FOV: 45 degrees; color fundus photograph: 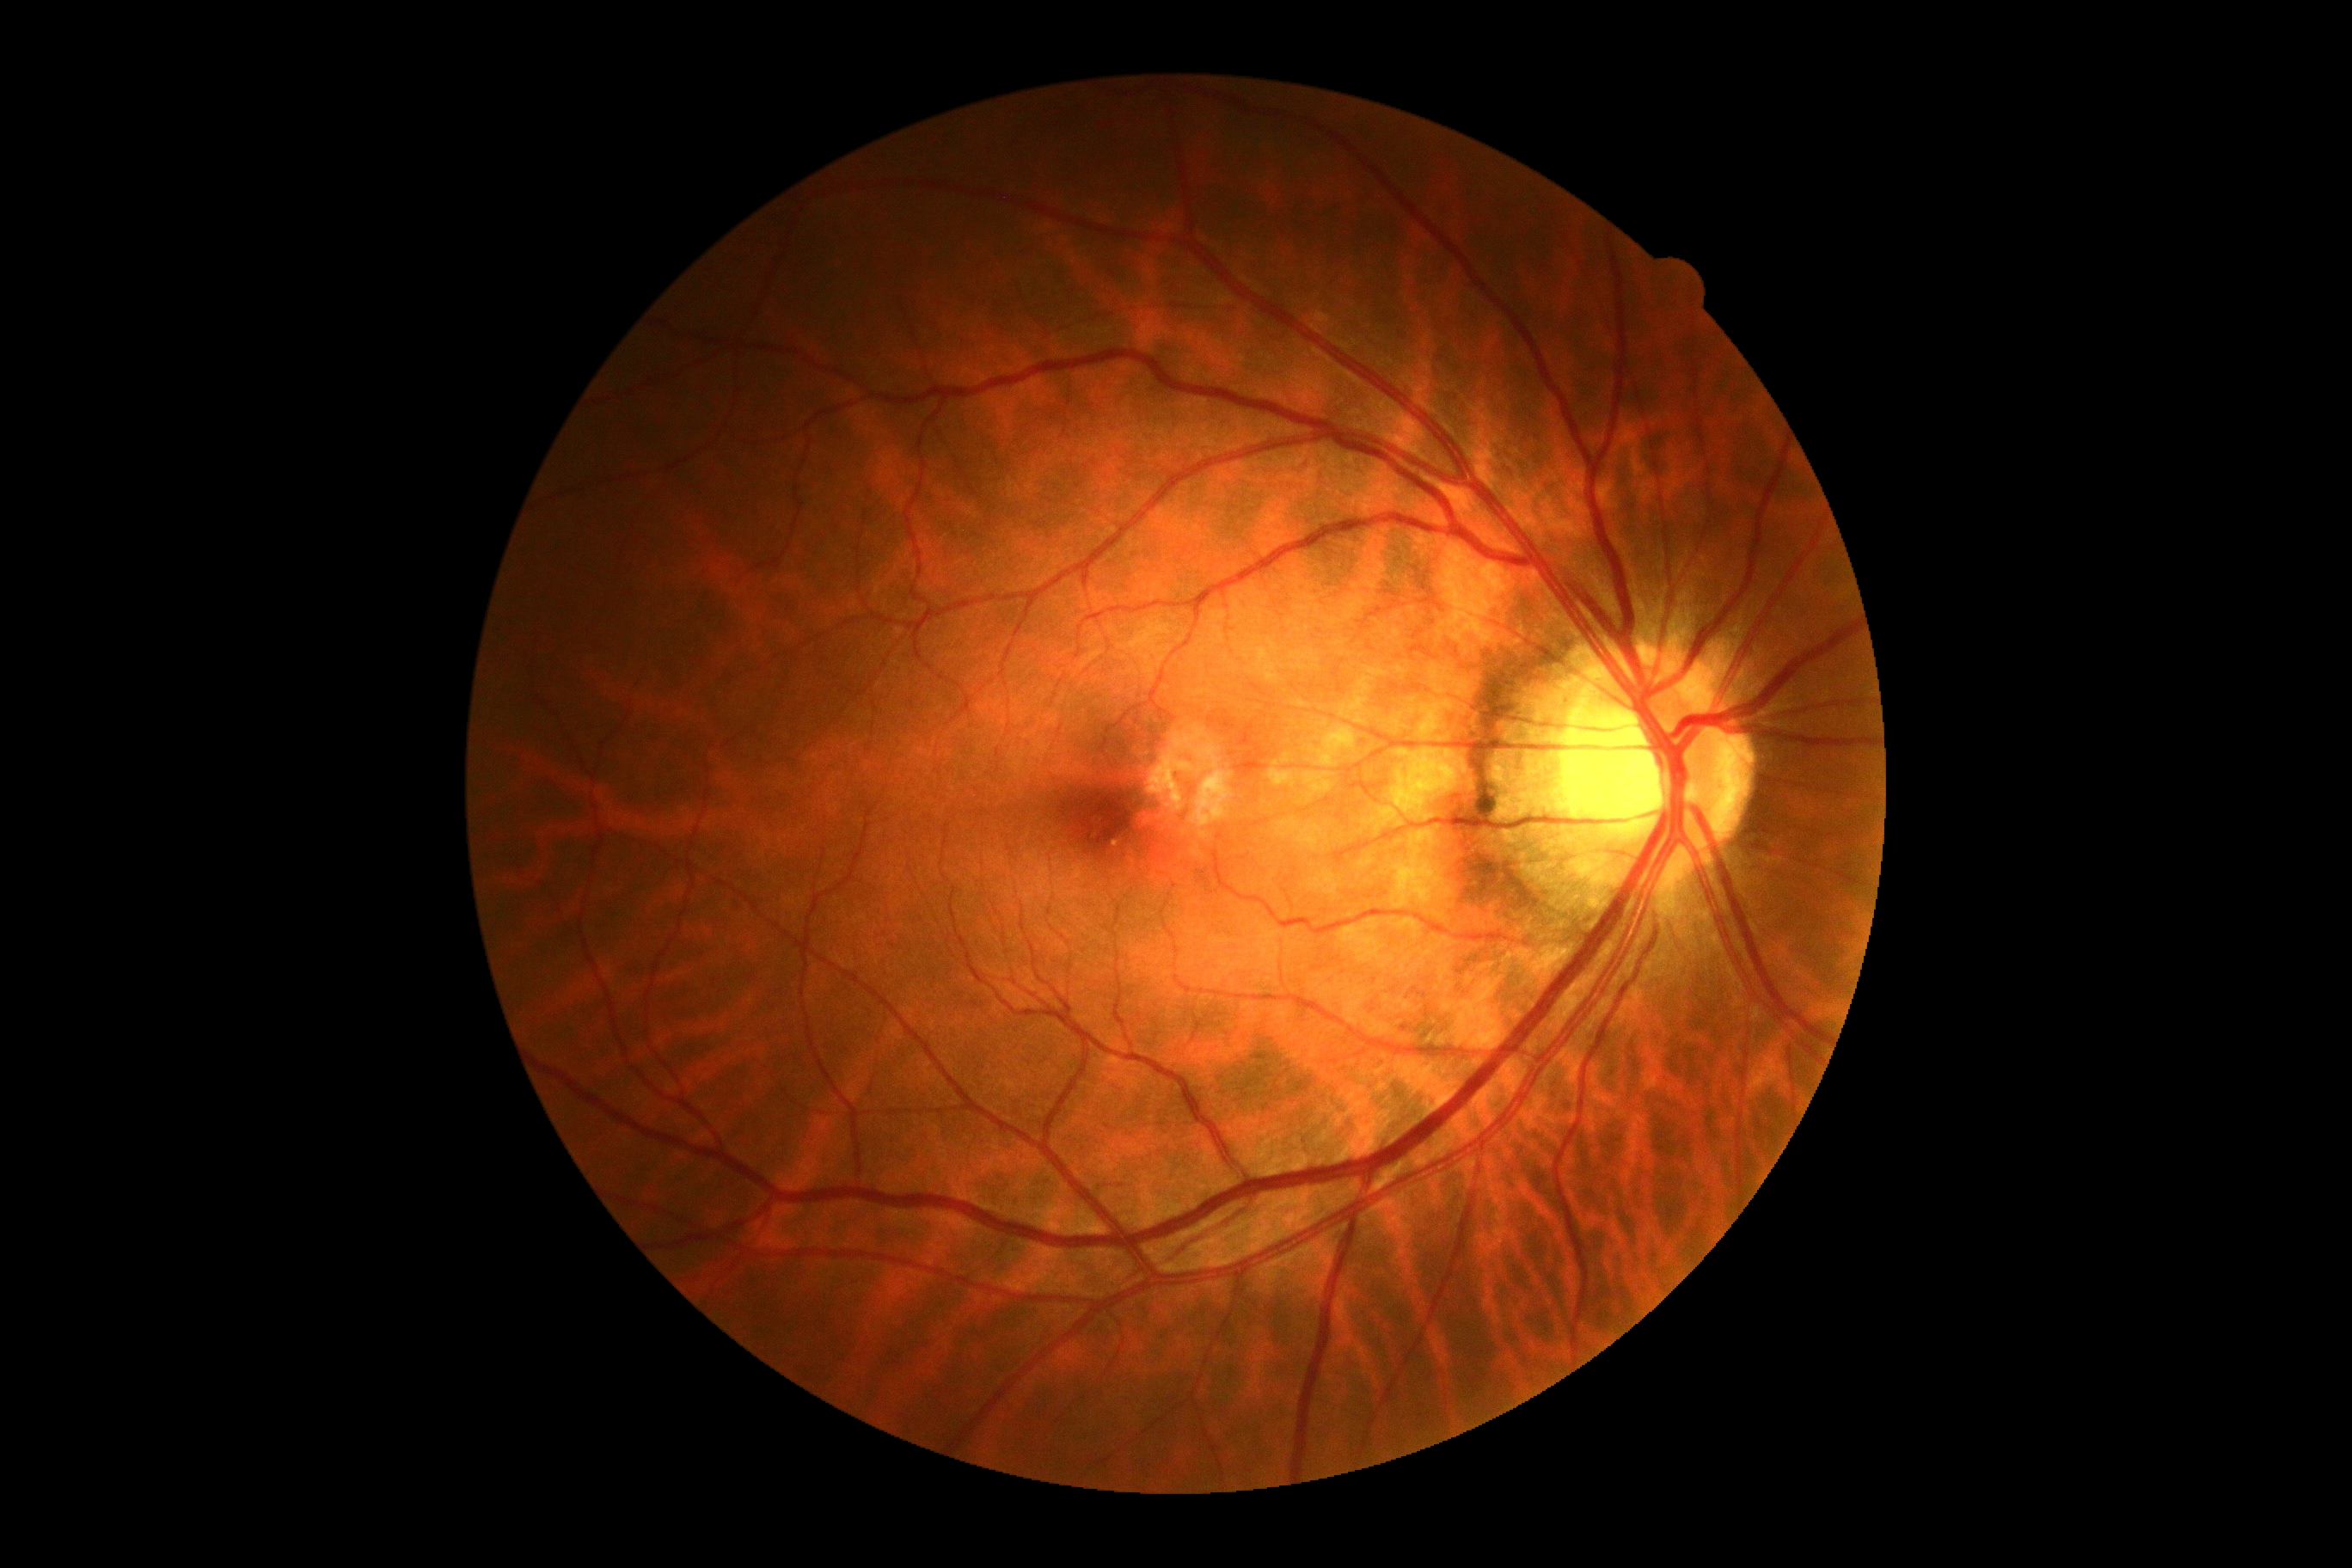
Diabetic retinopathy (DR) is 0/4.